Pediatric wide-field fundus photograph:
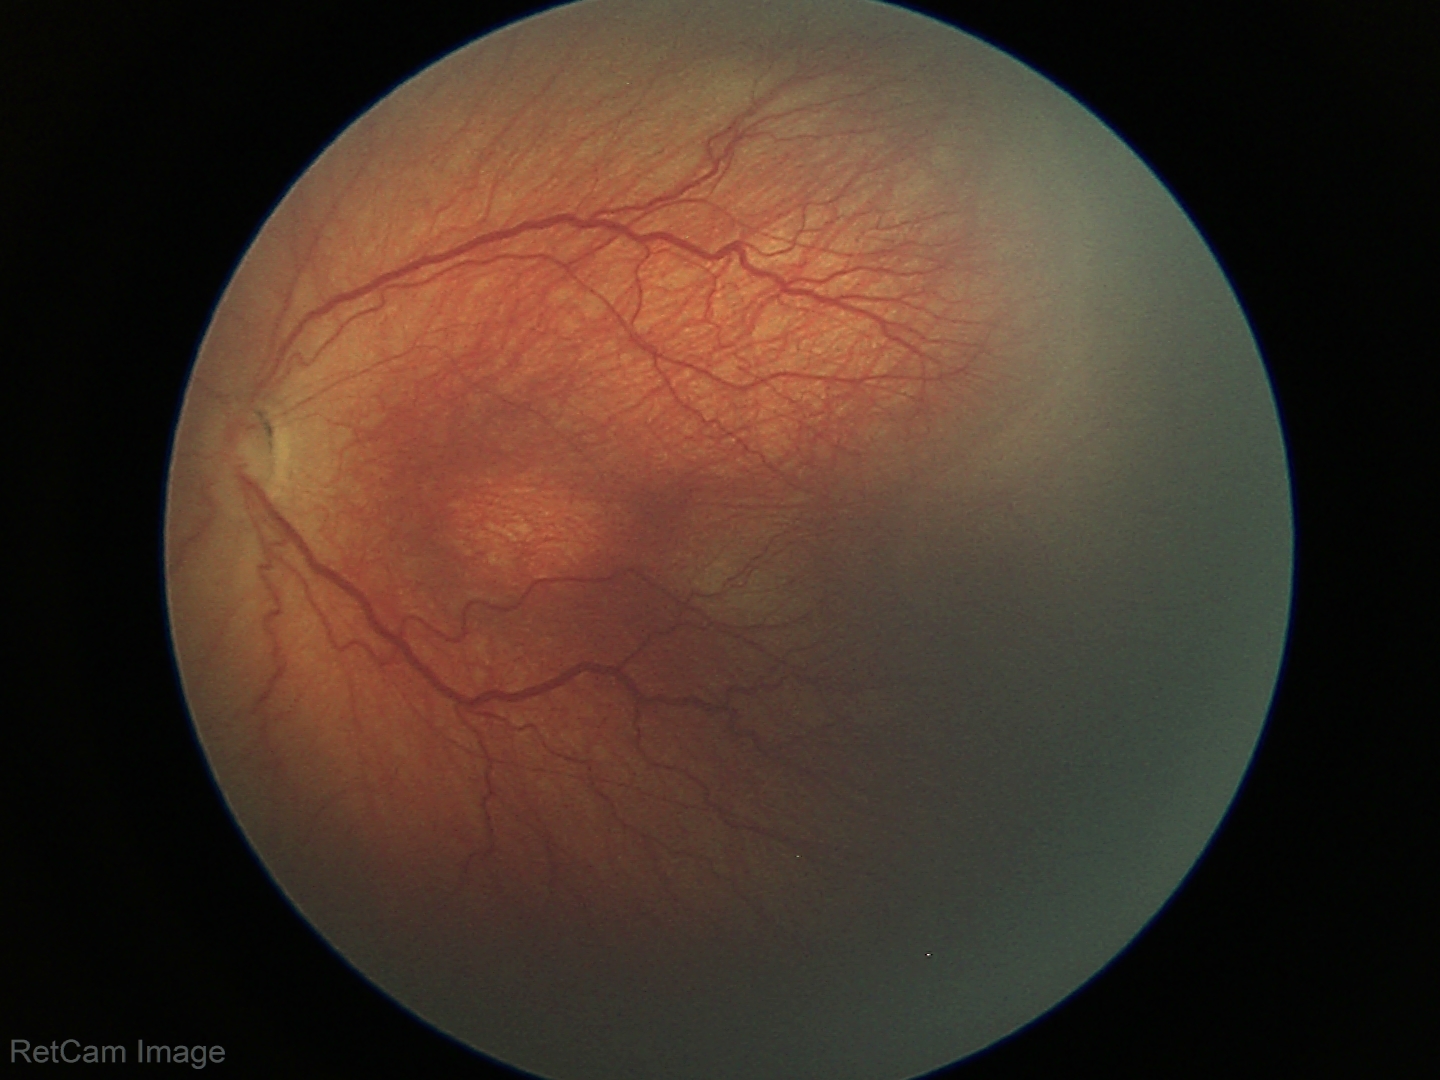 Examination diagnosed as retinopathy of prematurity stage 3.
Without plus disease.